CFP, Kowa VX-10α, 2361 x 1568 pixels — 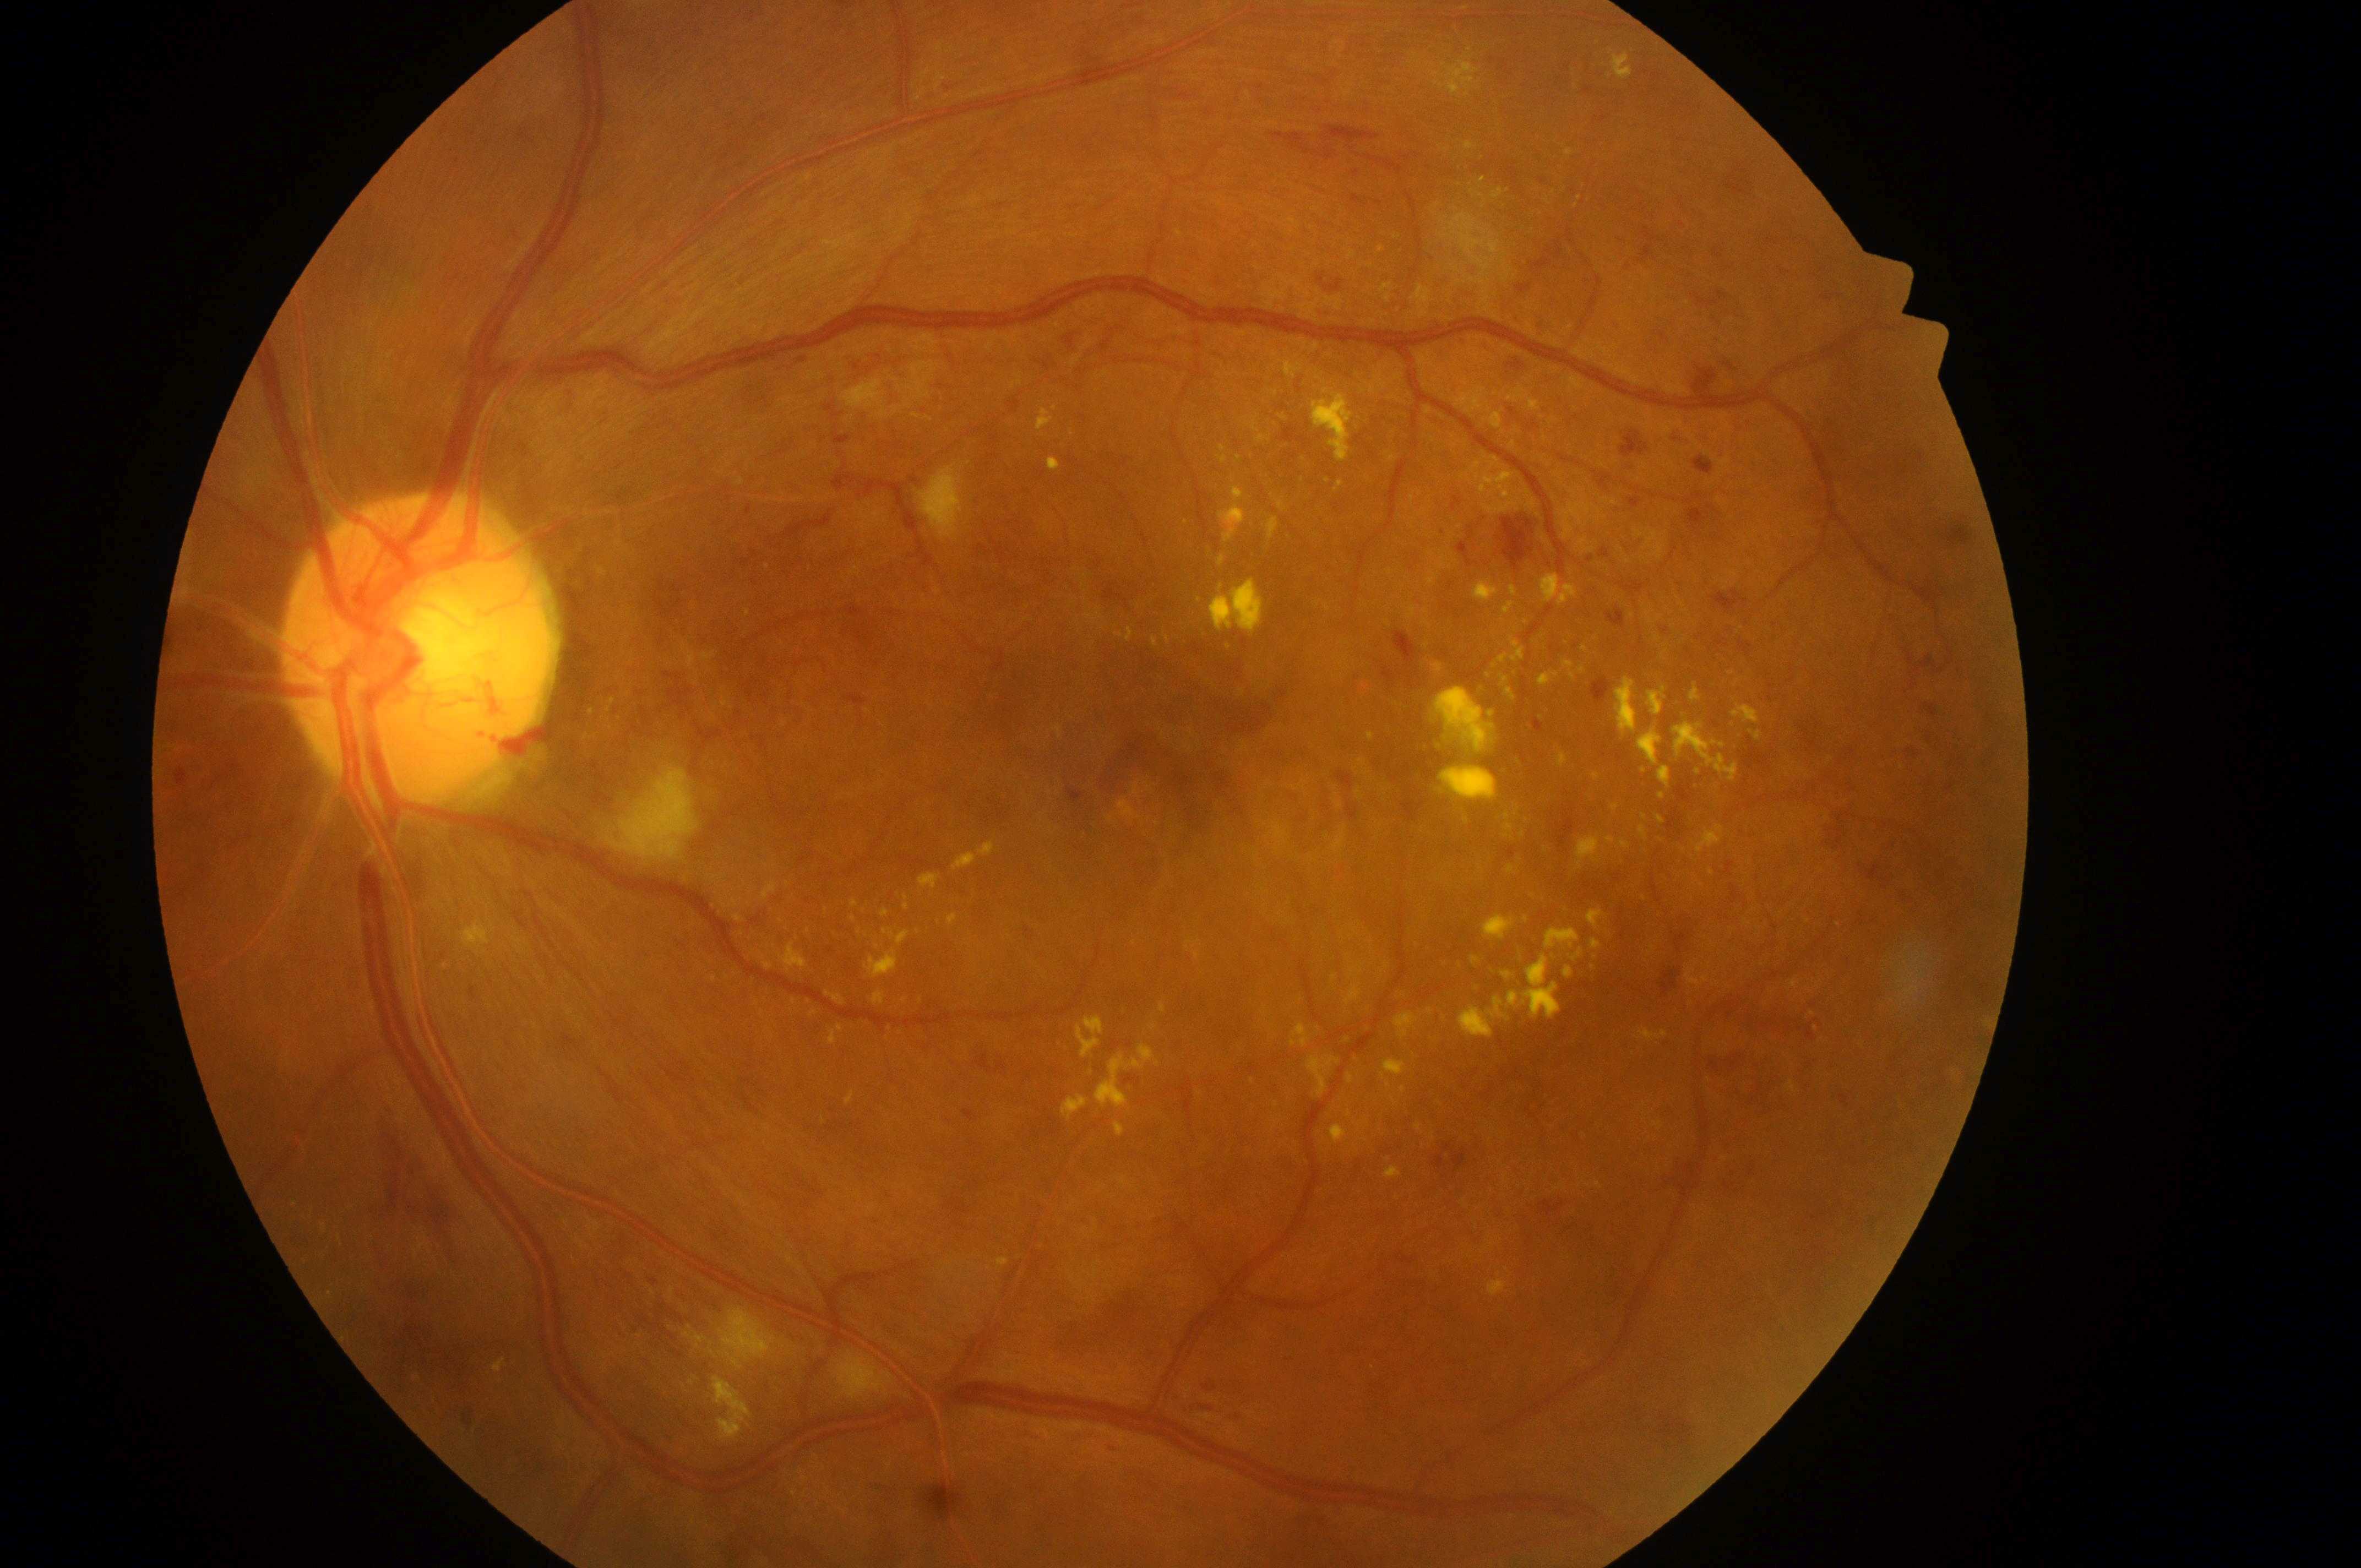 optic disc center = (416, 657)
macula center = (1149, 742)
DME = high risk (grade 2)
laterality = oculus sinister
DR = grade 4 (PDR)